45° FOV. Retinal fundus photograph. 2346 x 1568 pixels: 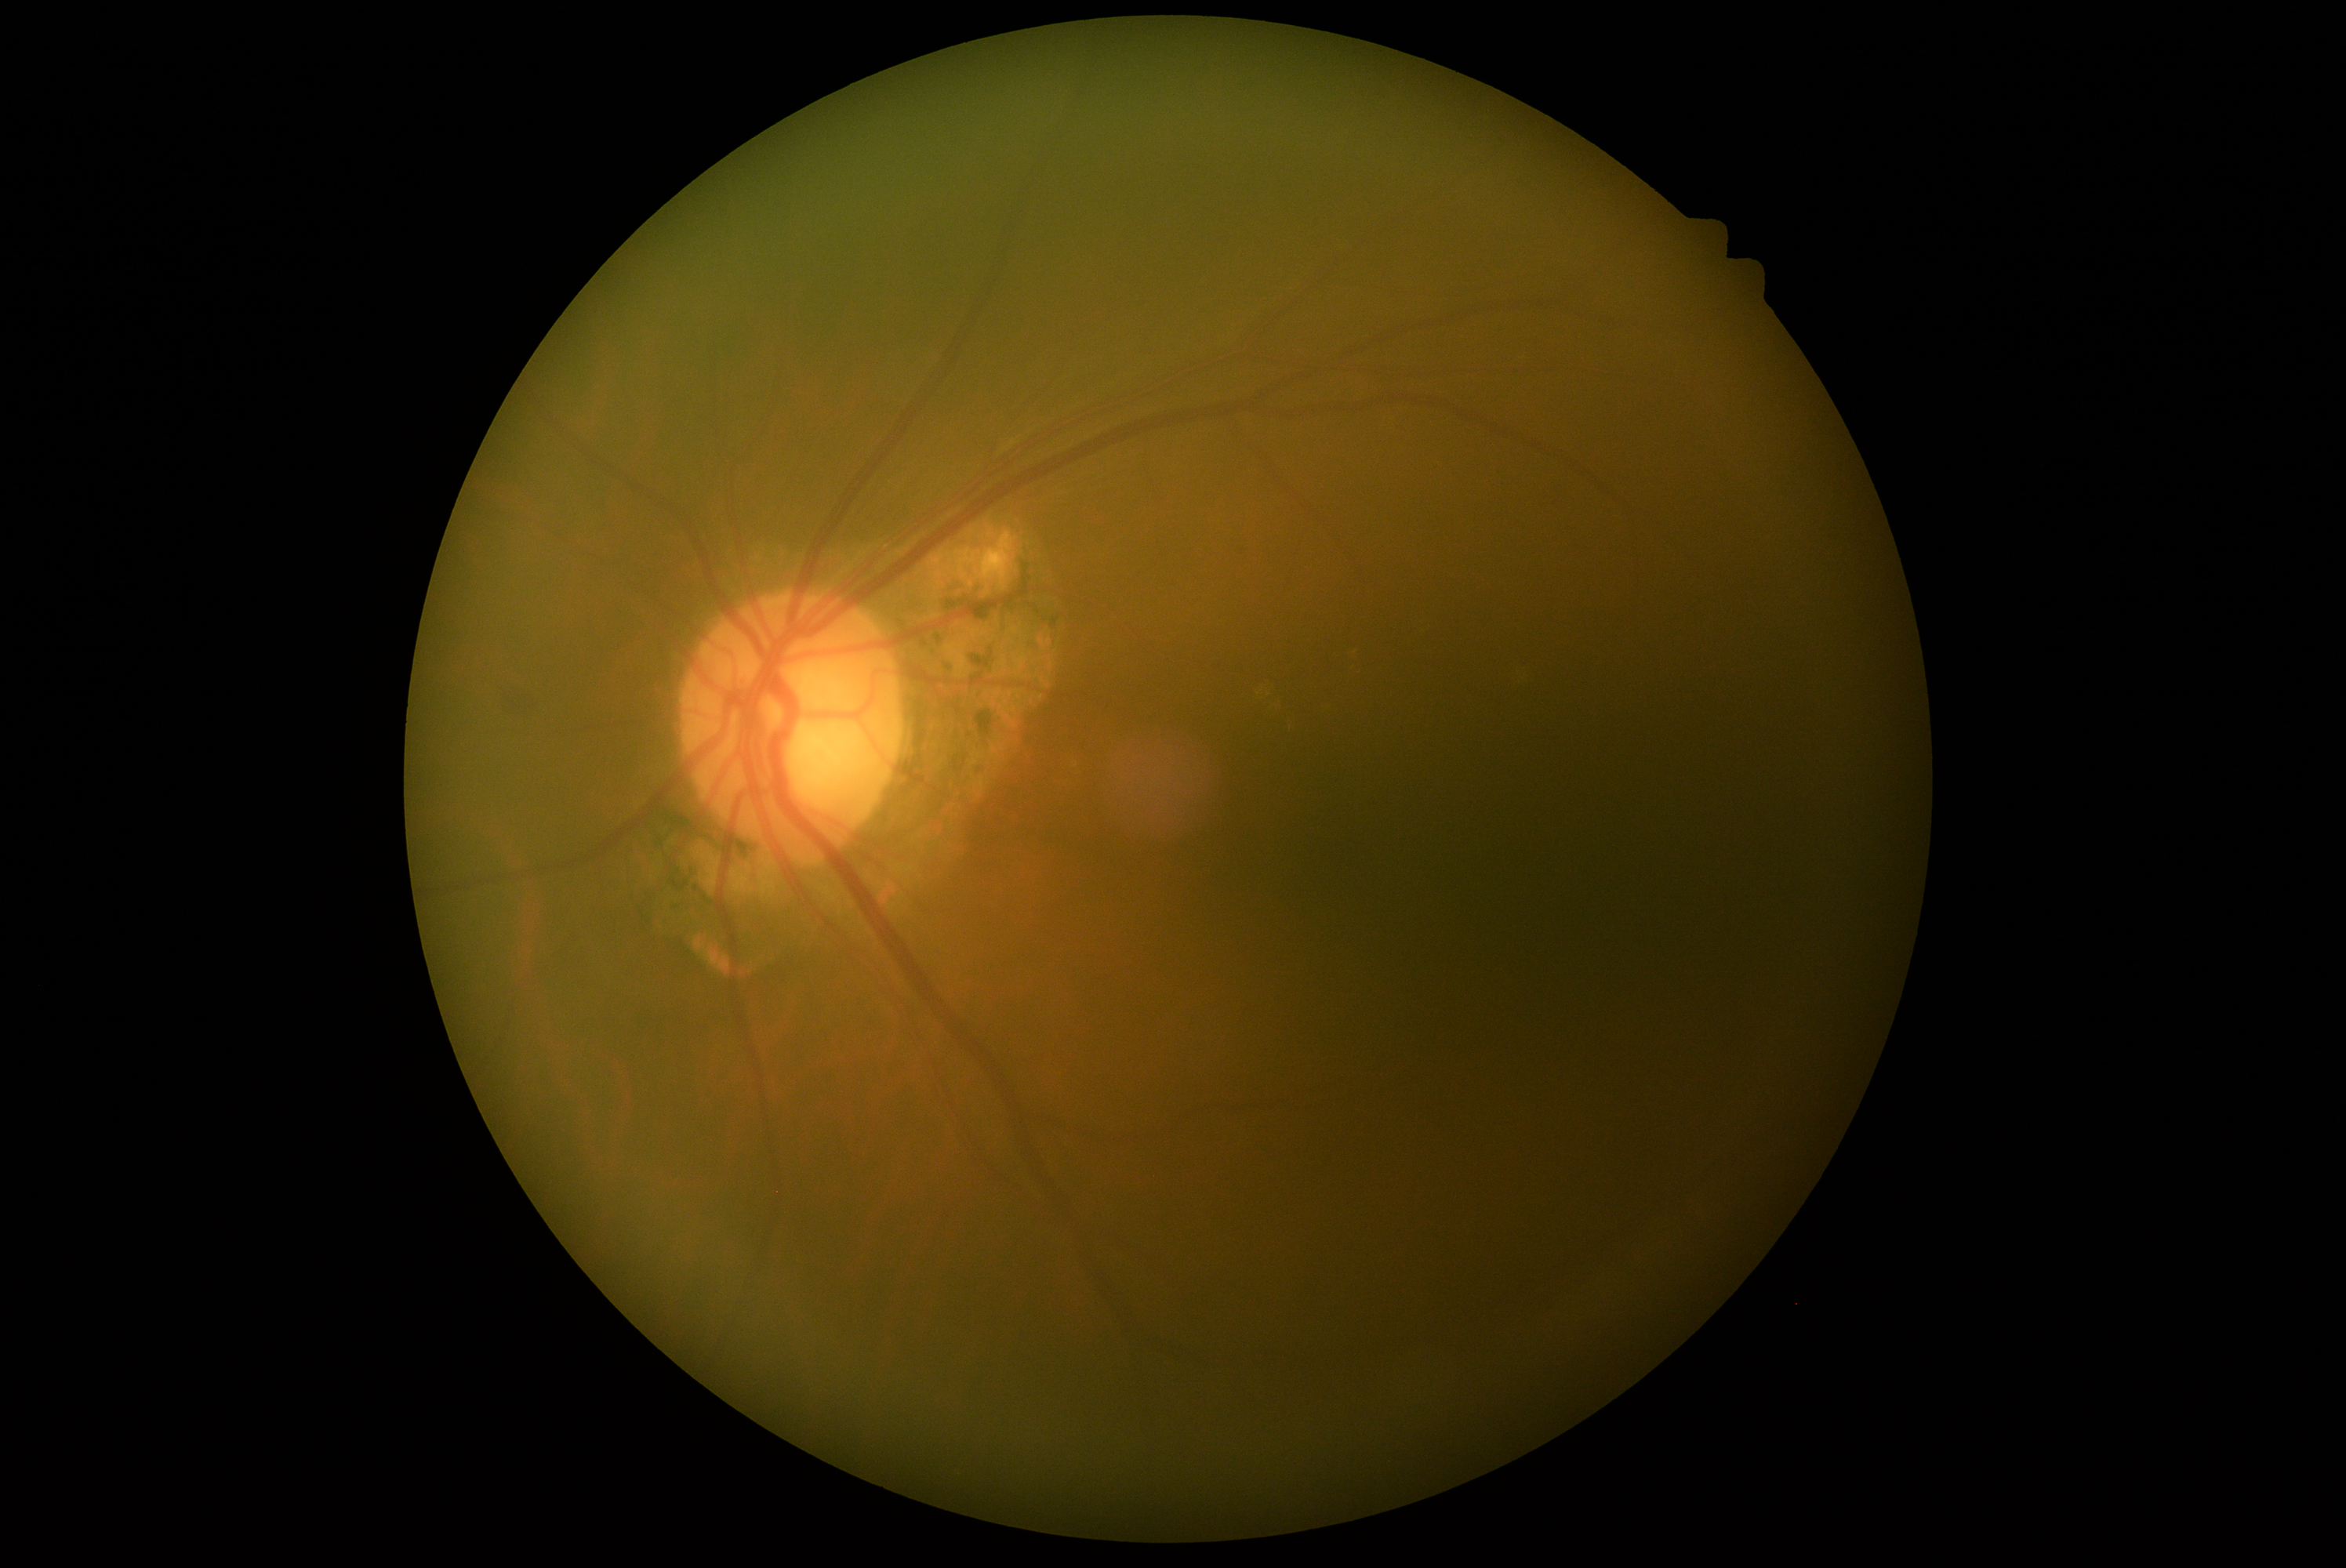
diabetic retinopathy (DR): moderate non-proliferative diabetic retinopathy (grade 2).